45-degree field of view:
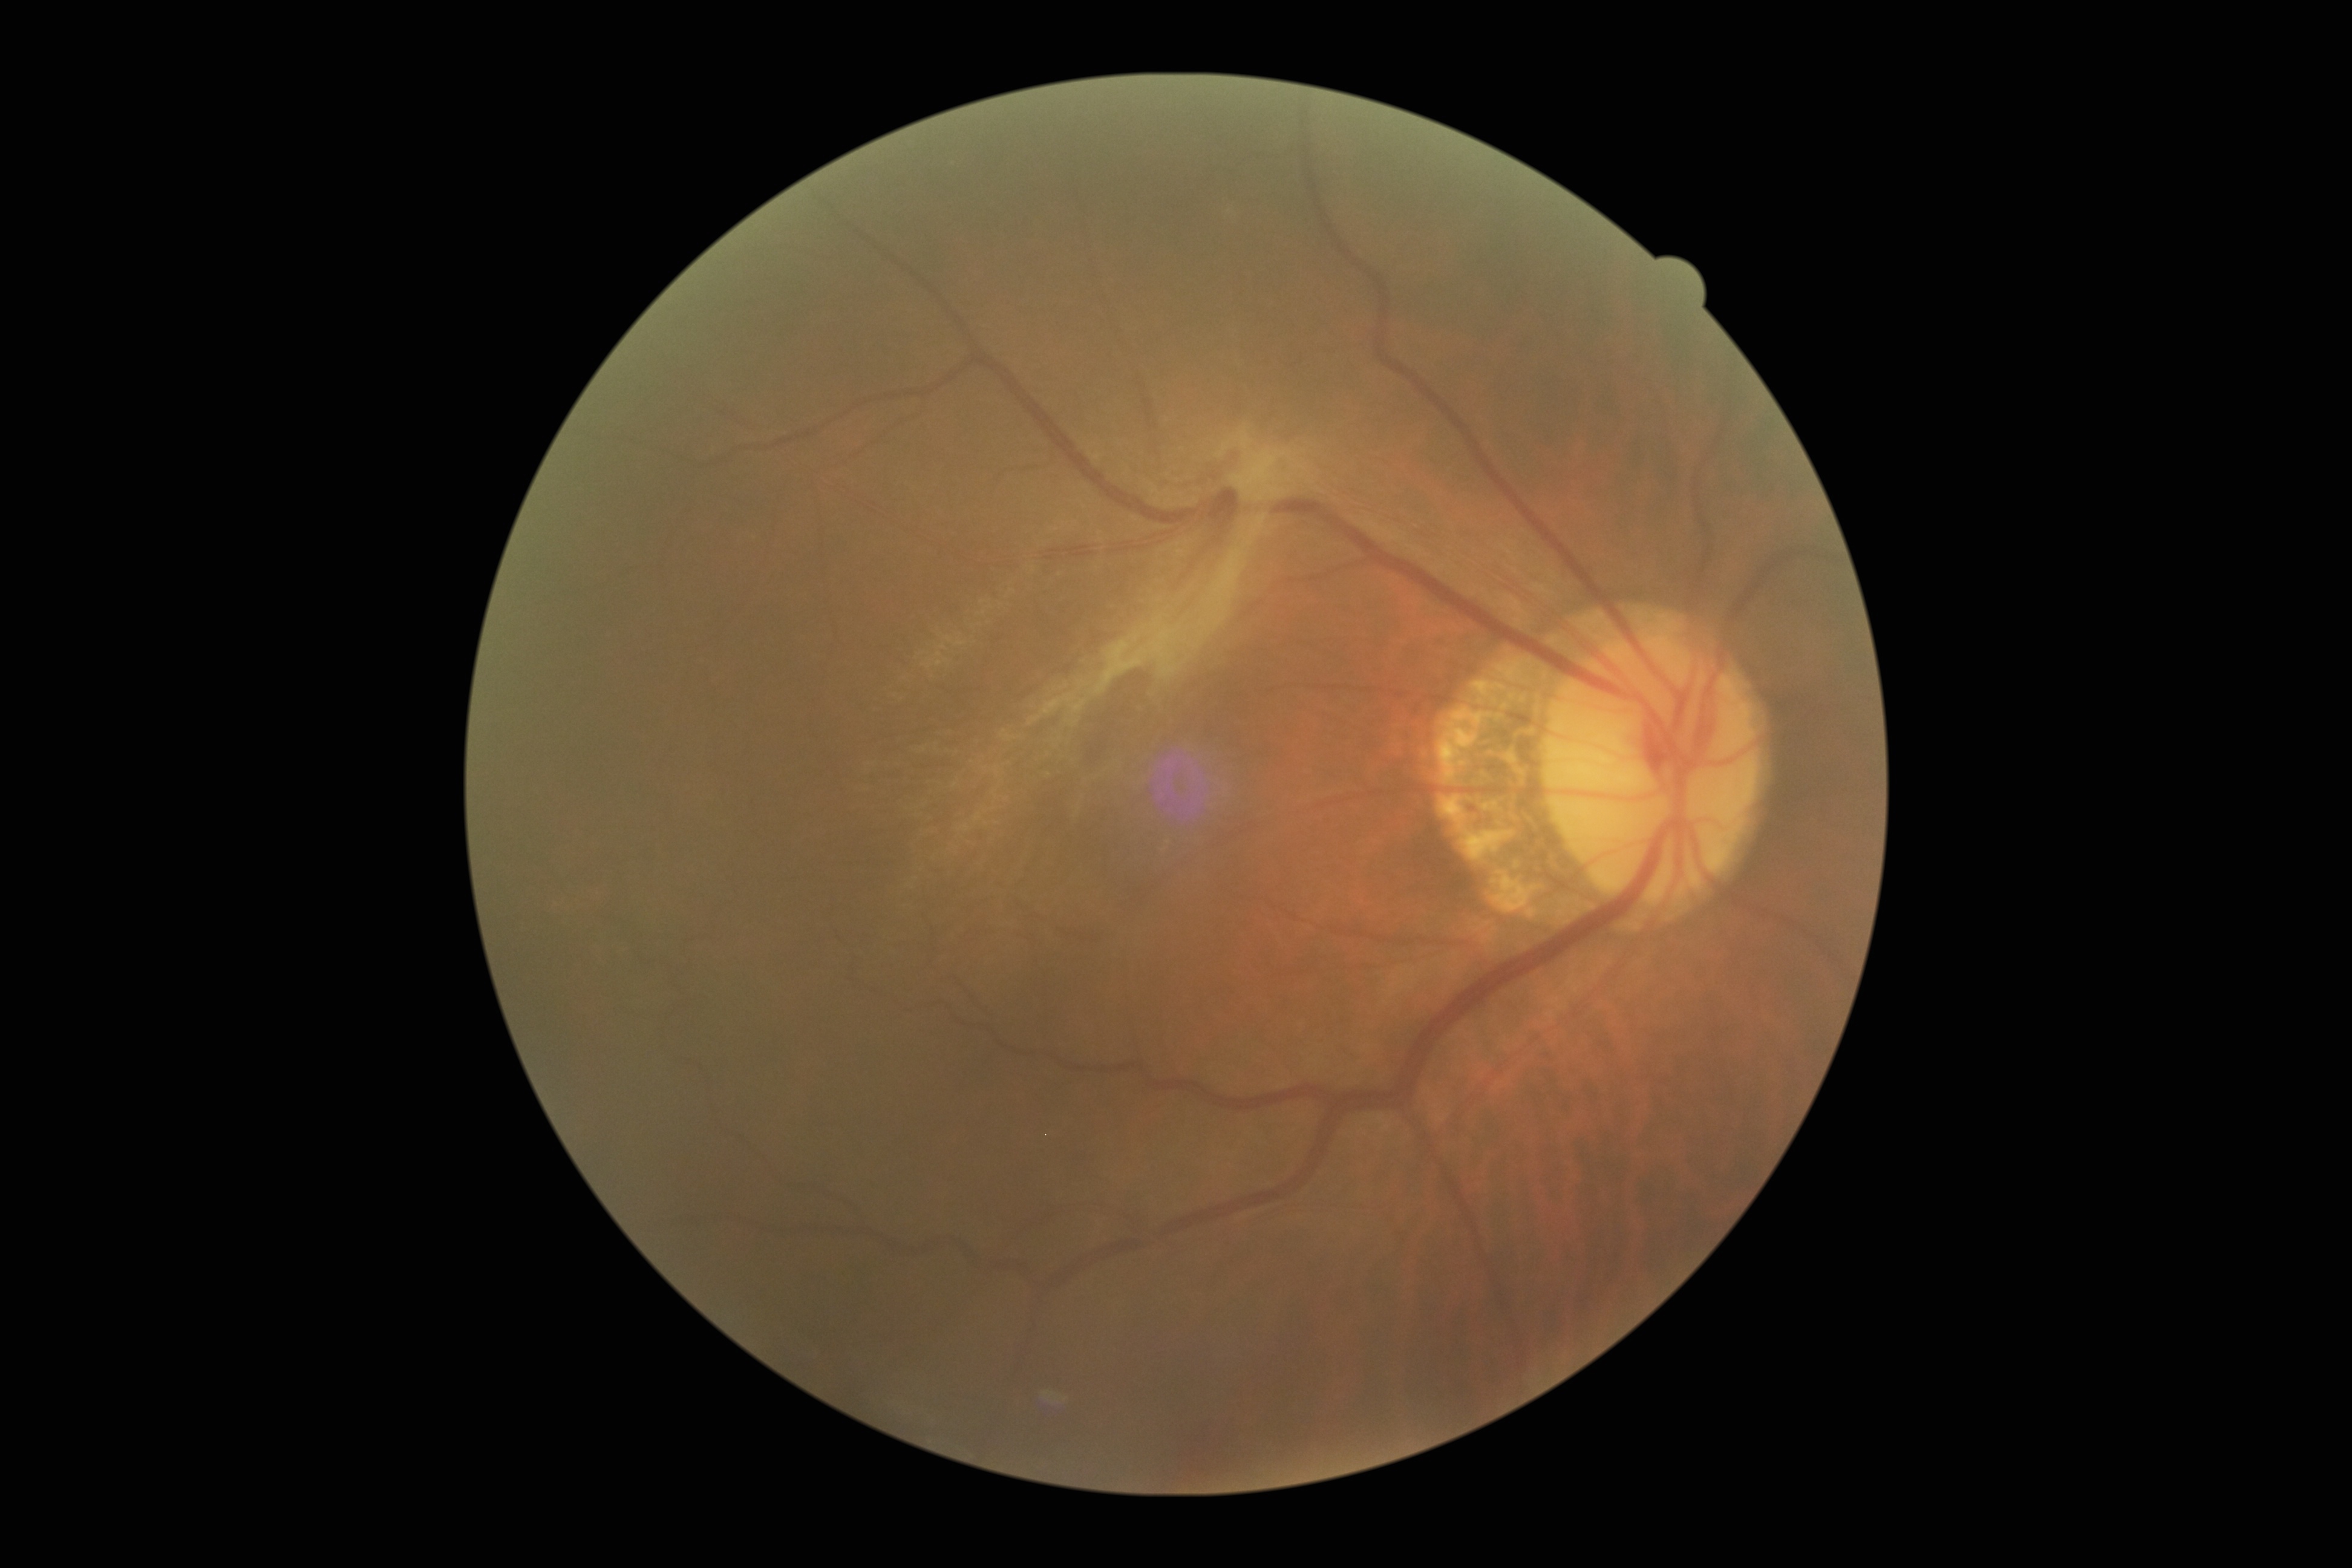
diabetic retinopathy severity=4.